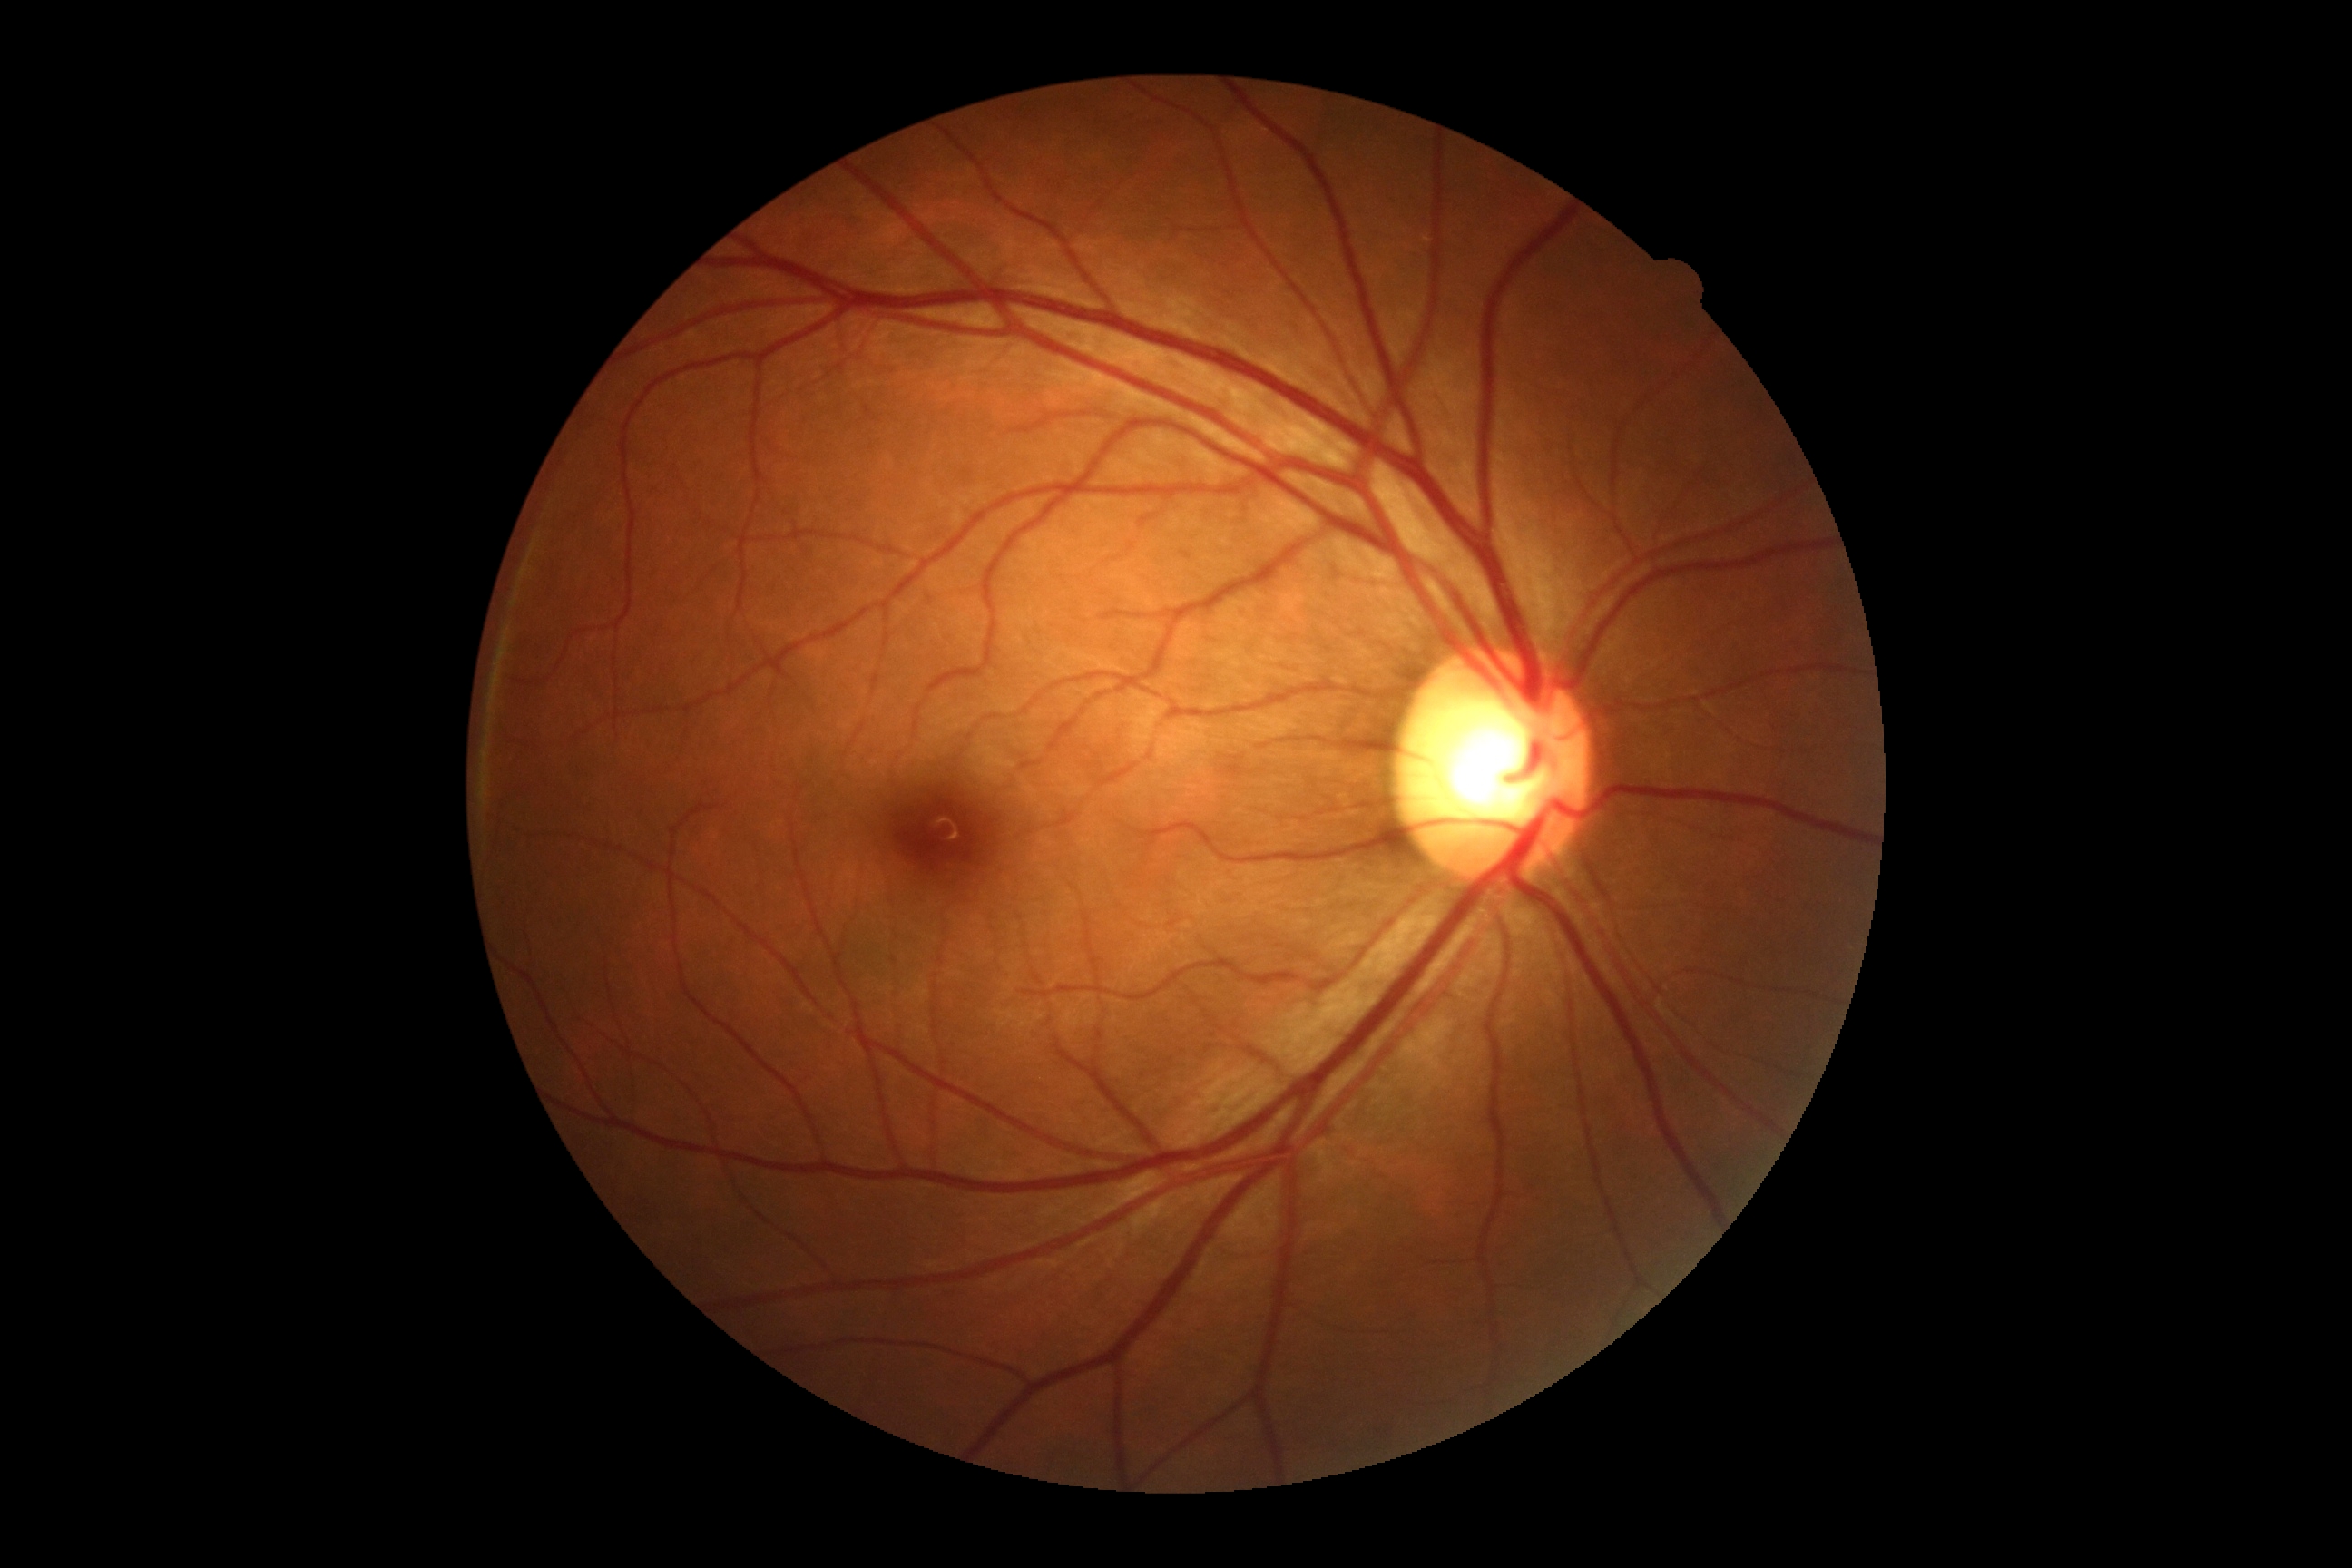

DR impression = no apparent DR; diabetic retinopathy (DR) = no apparent diabetic retinopathy (grade 0).